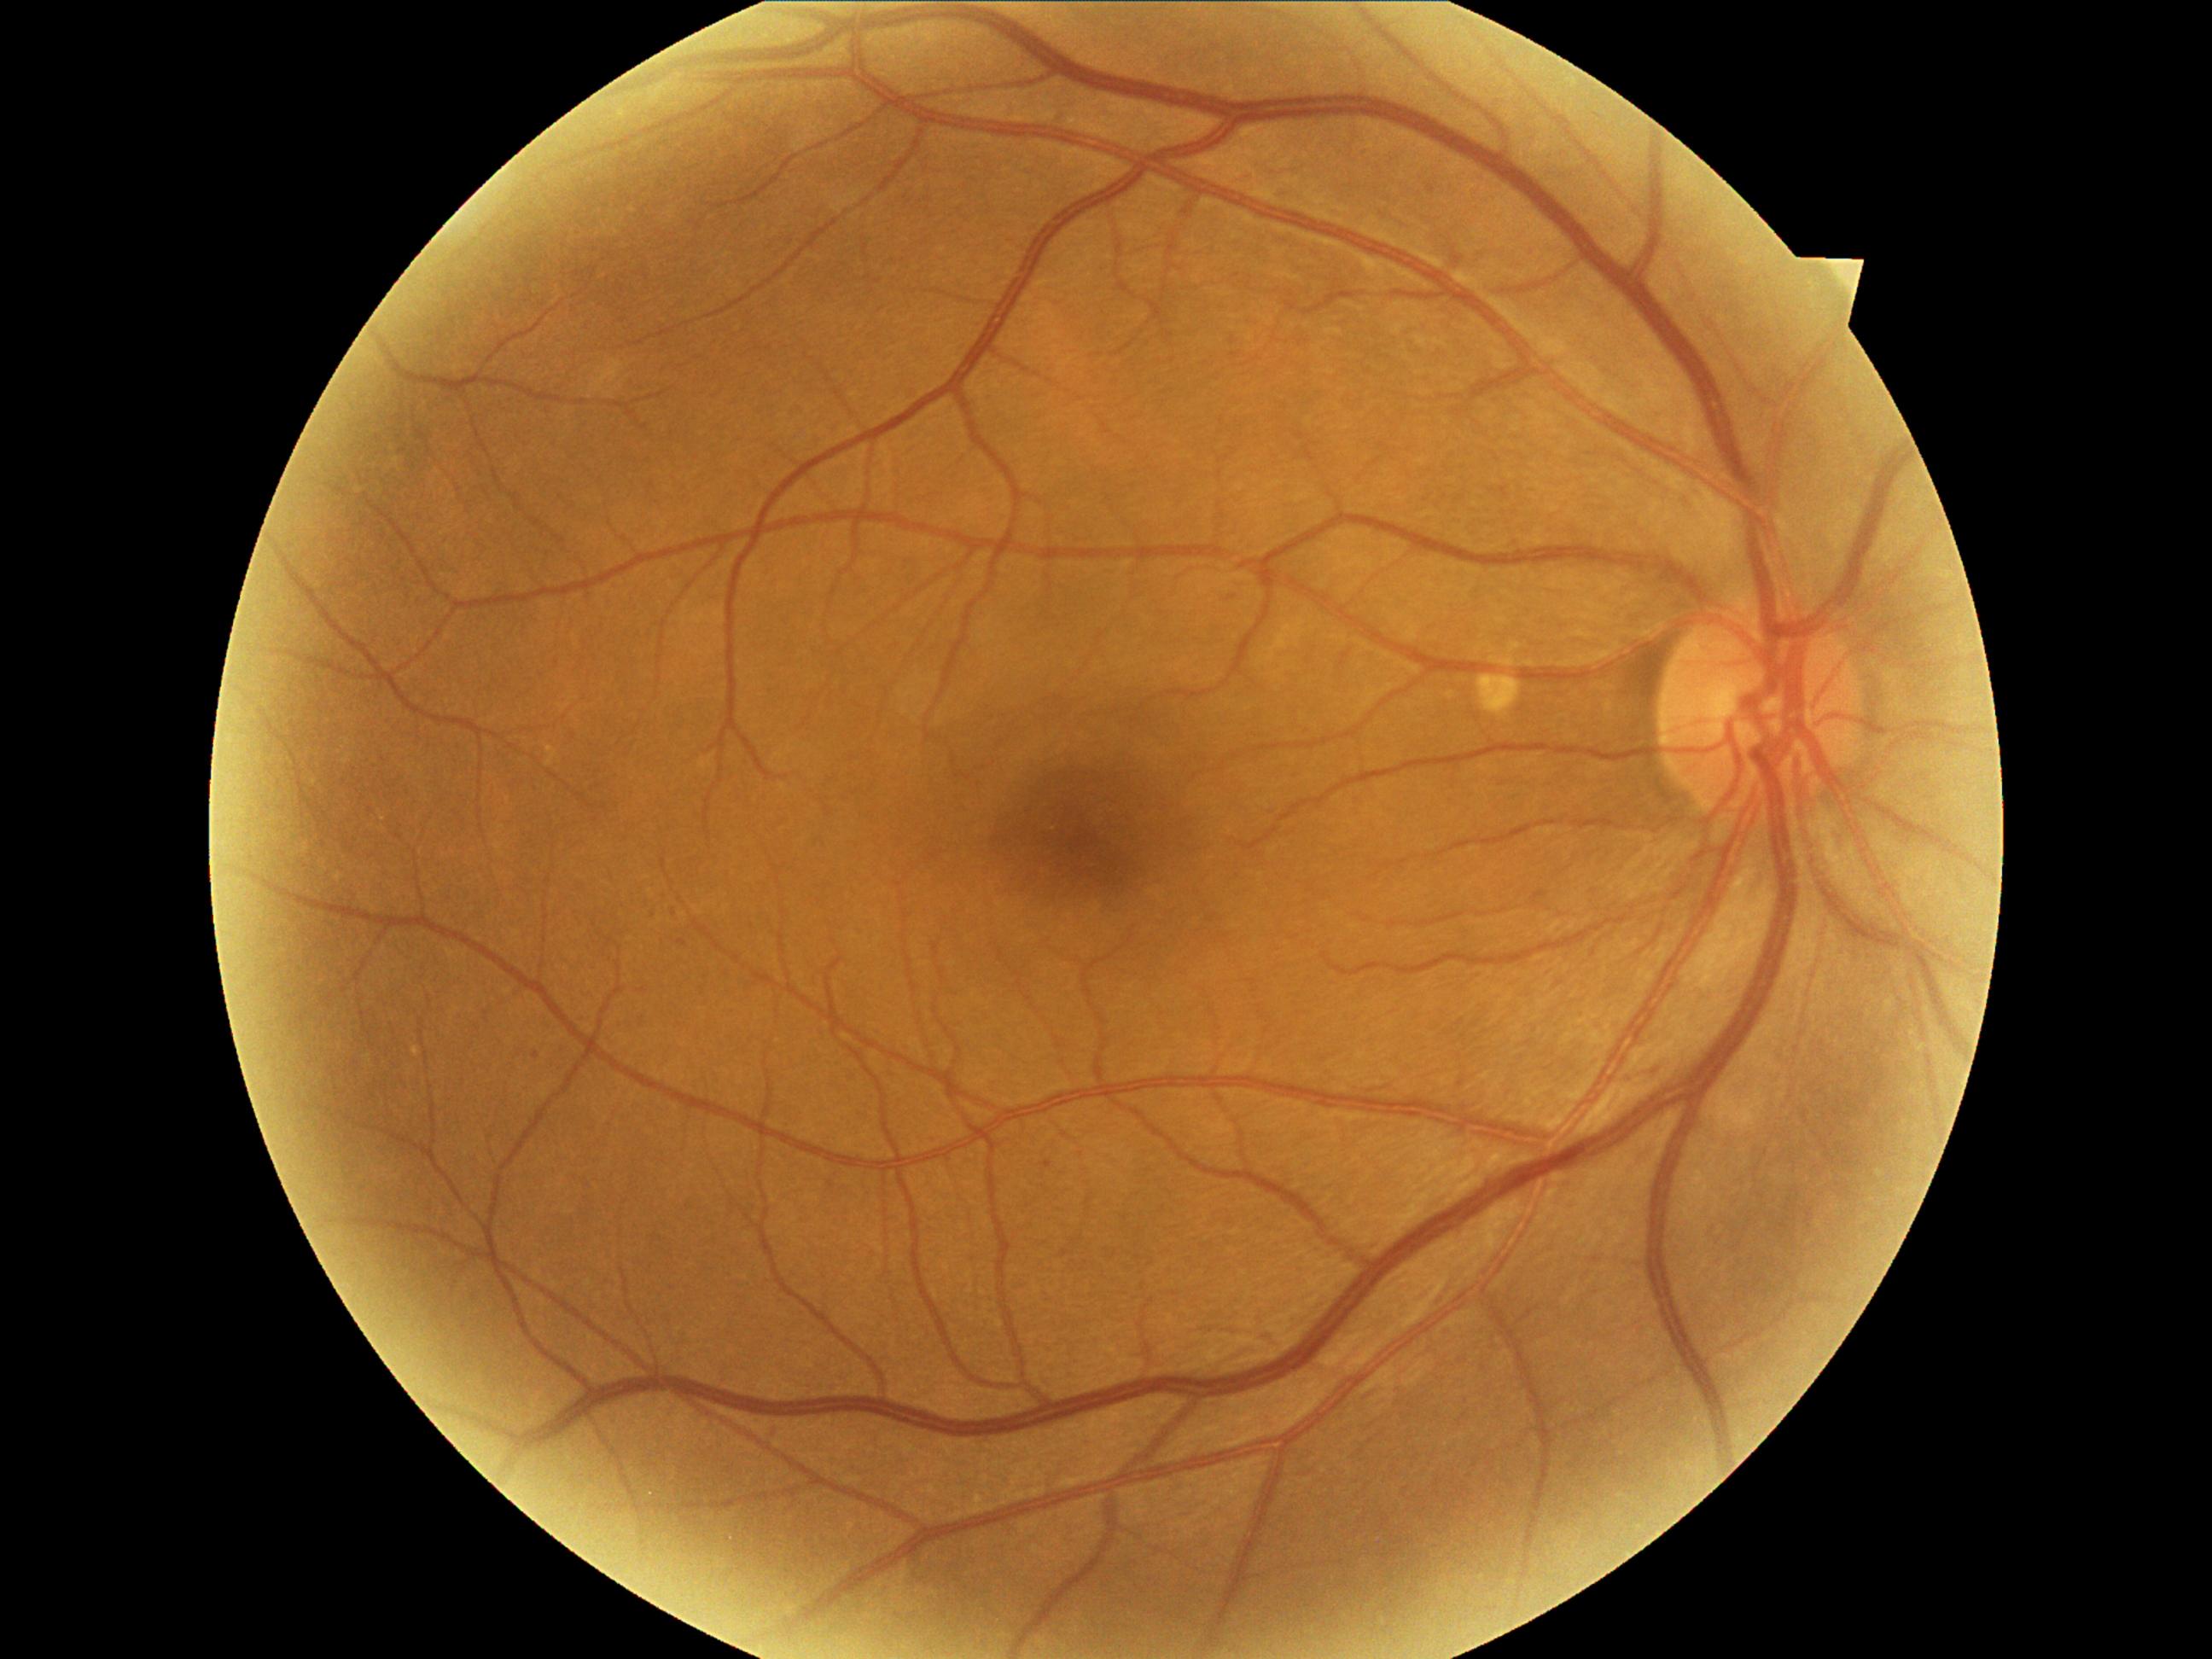
DR severity: 1/4.